Pediatric retinal photograph (wide-field):
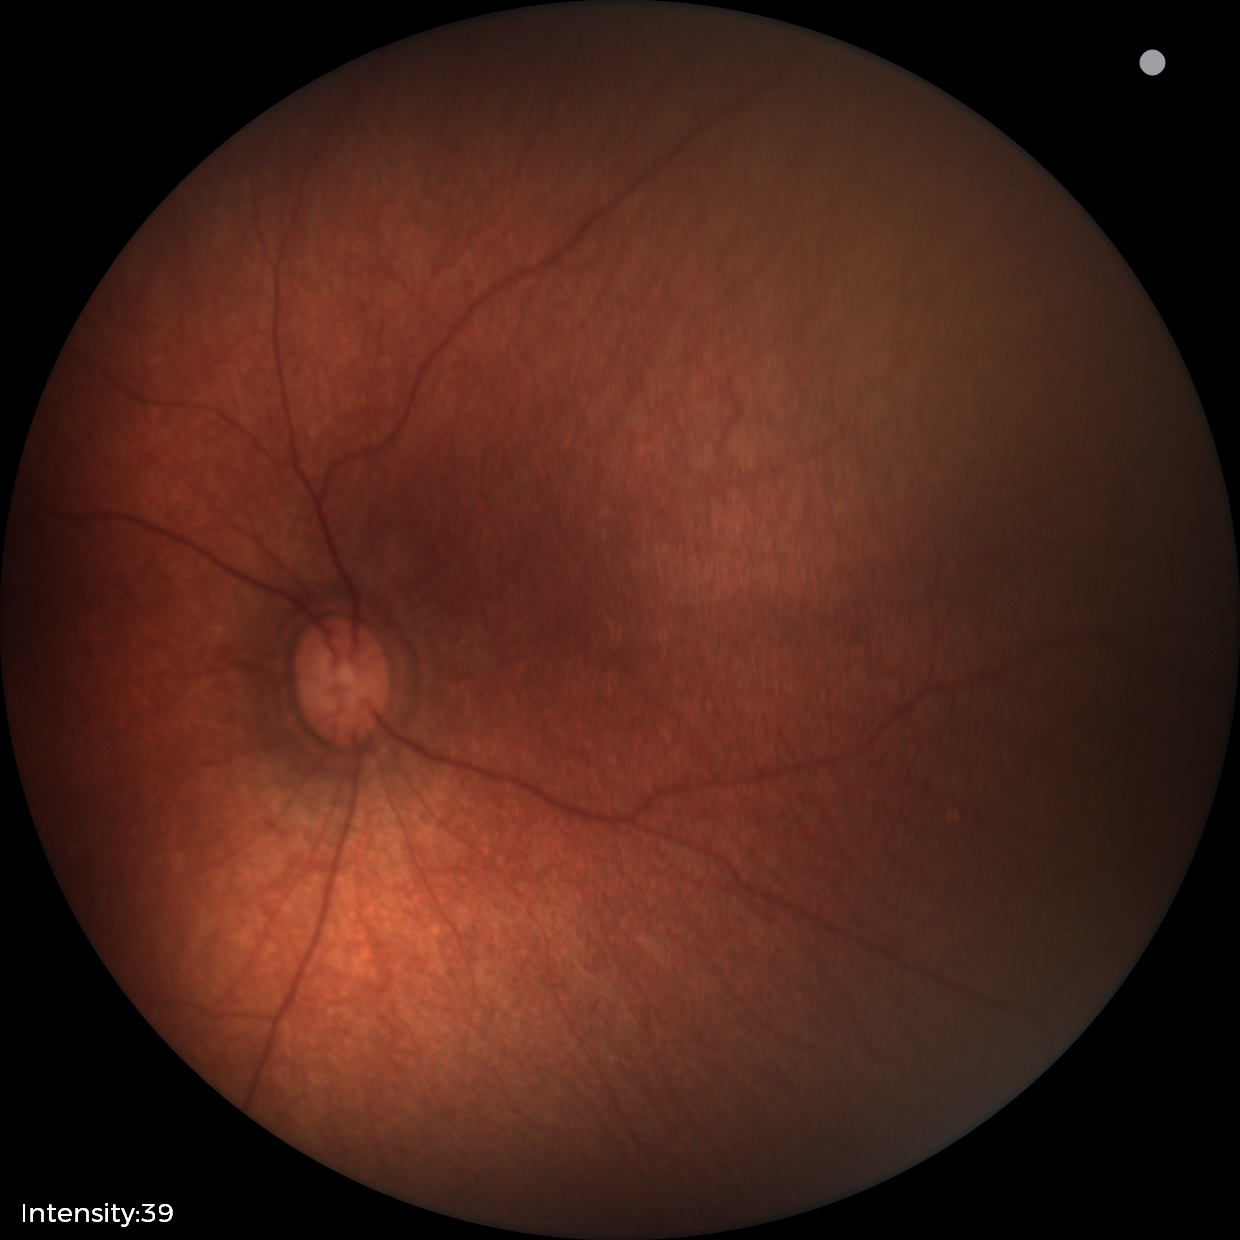

Screening examination diagnosed as physiological.